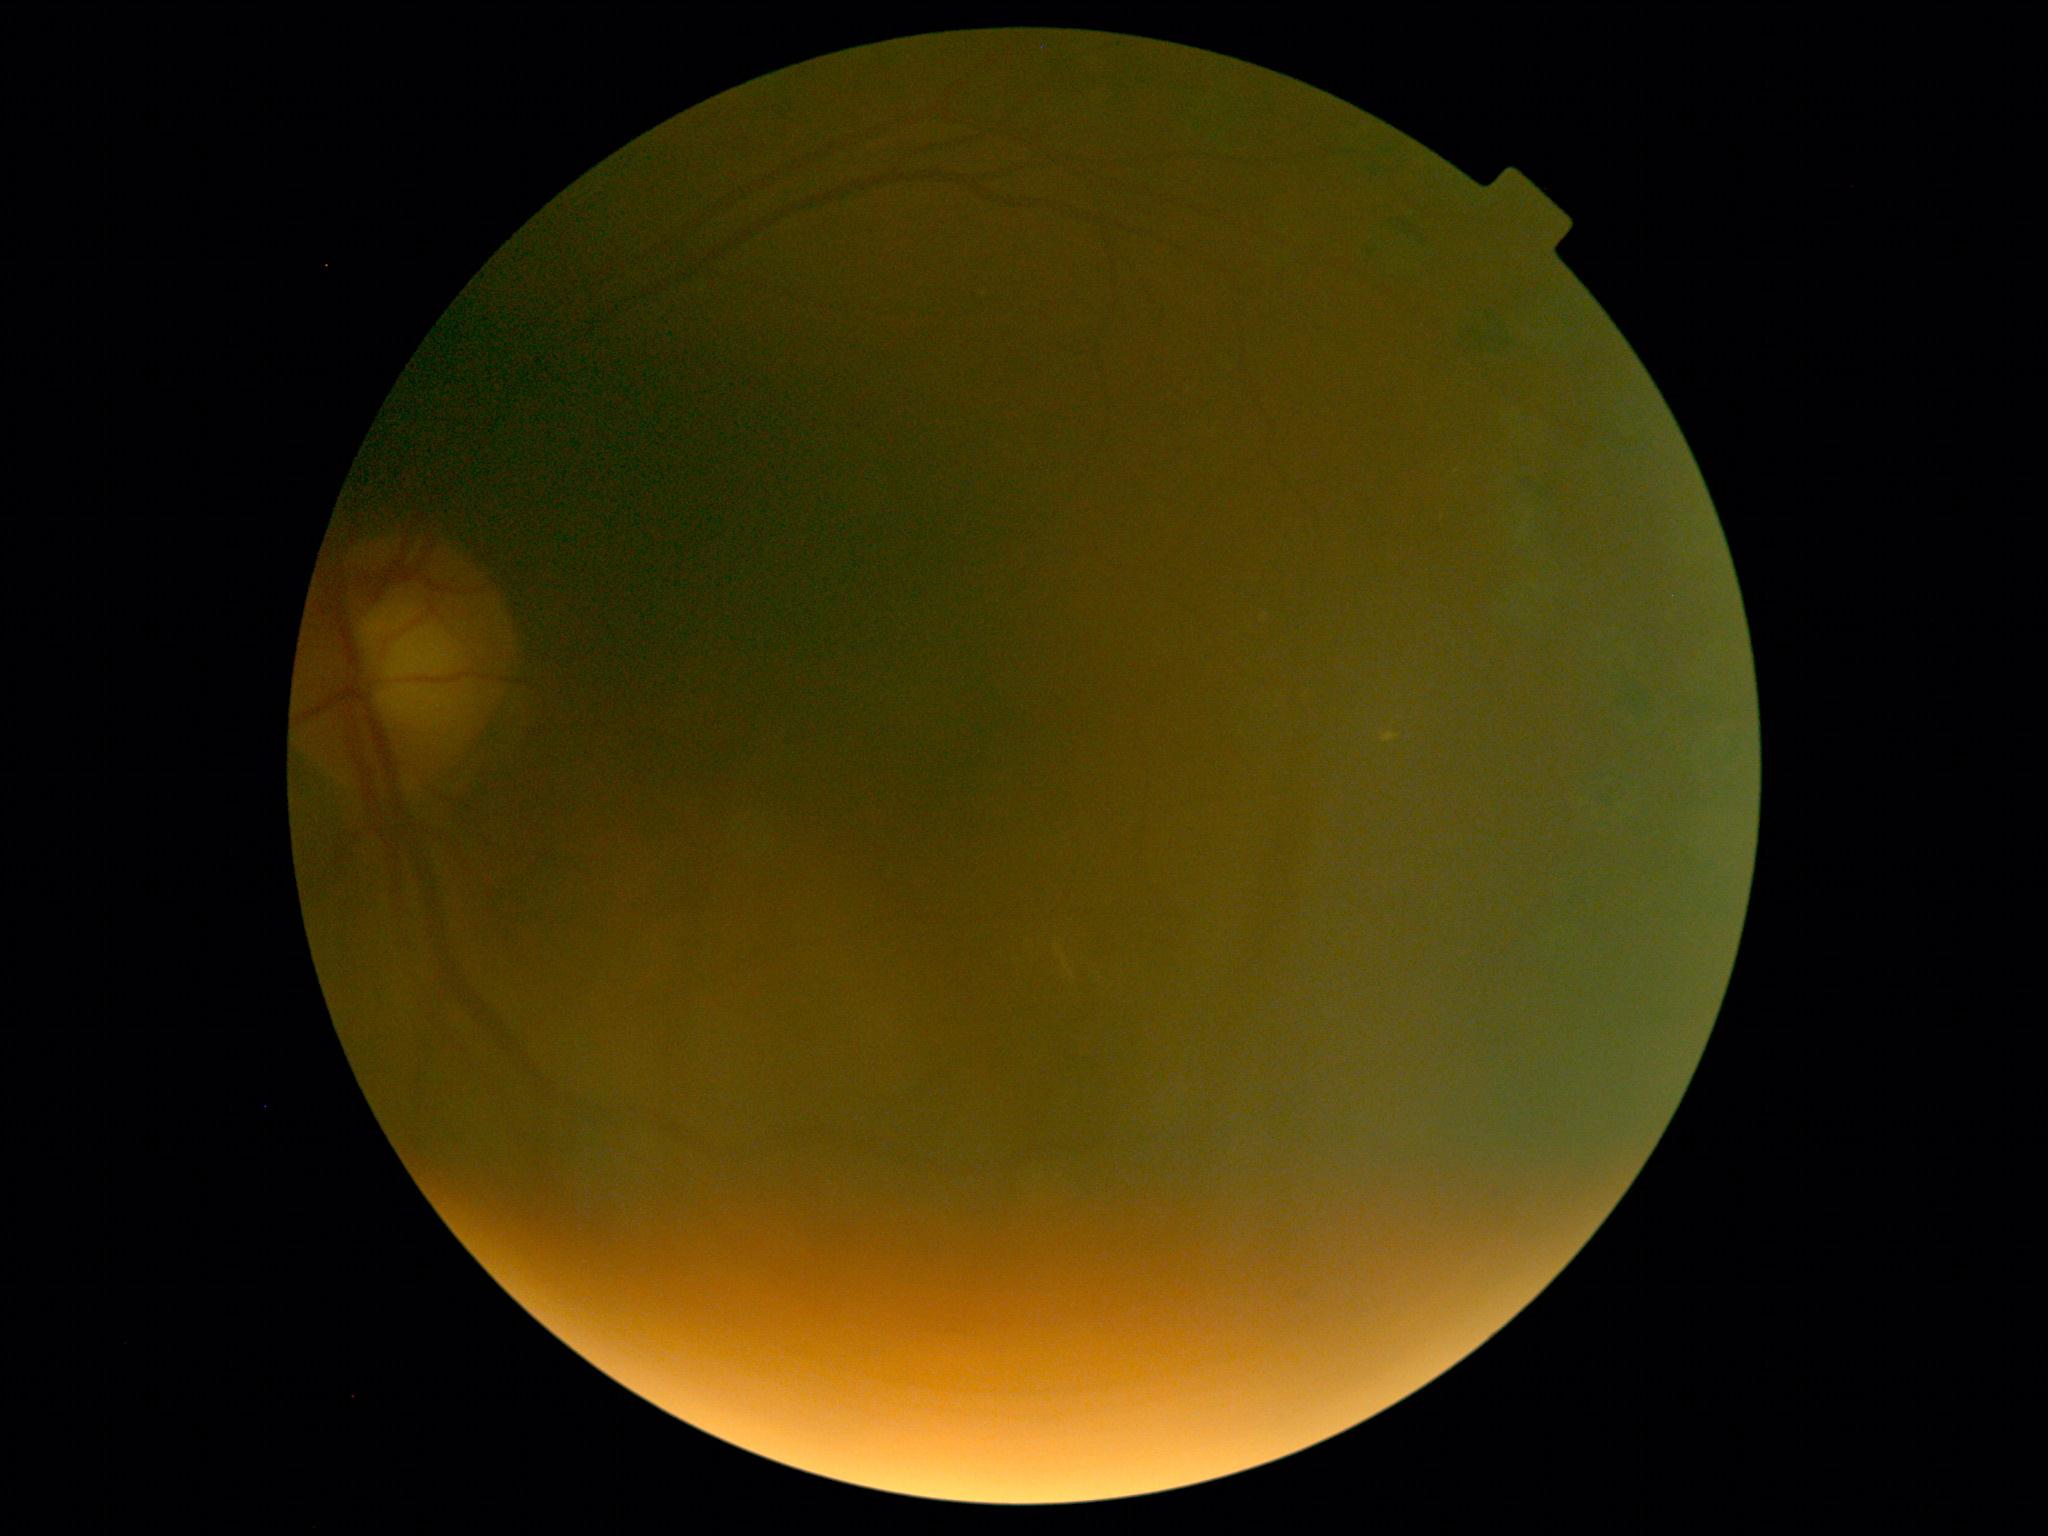
DR: grade 2 (moderate NPDR).